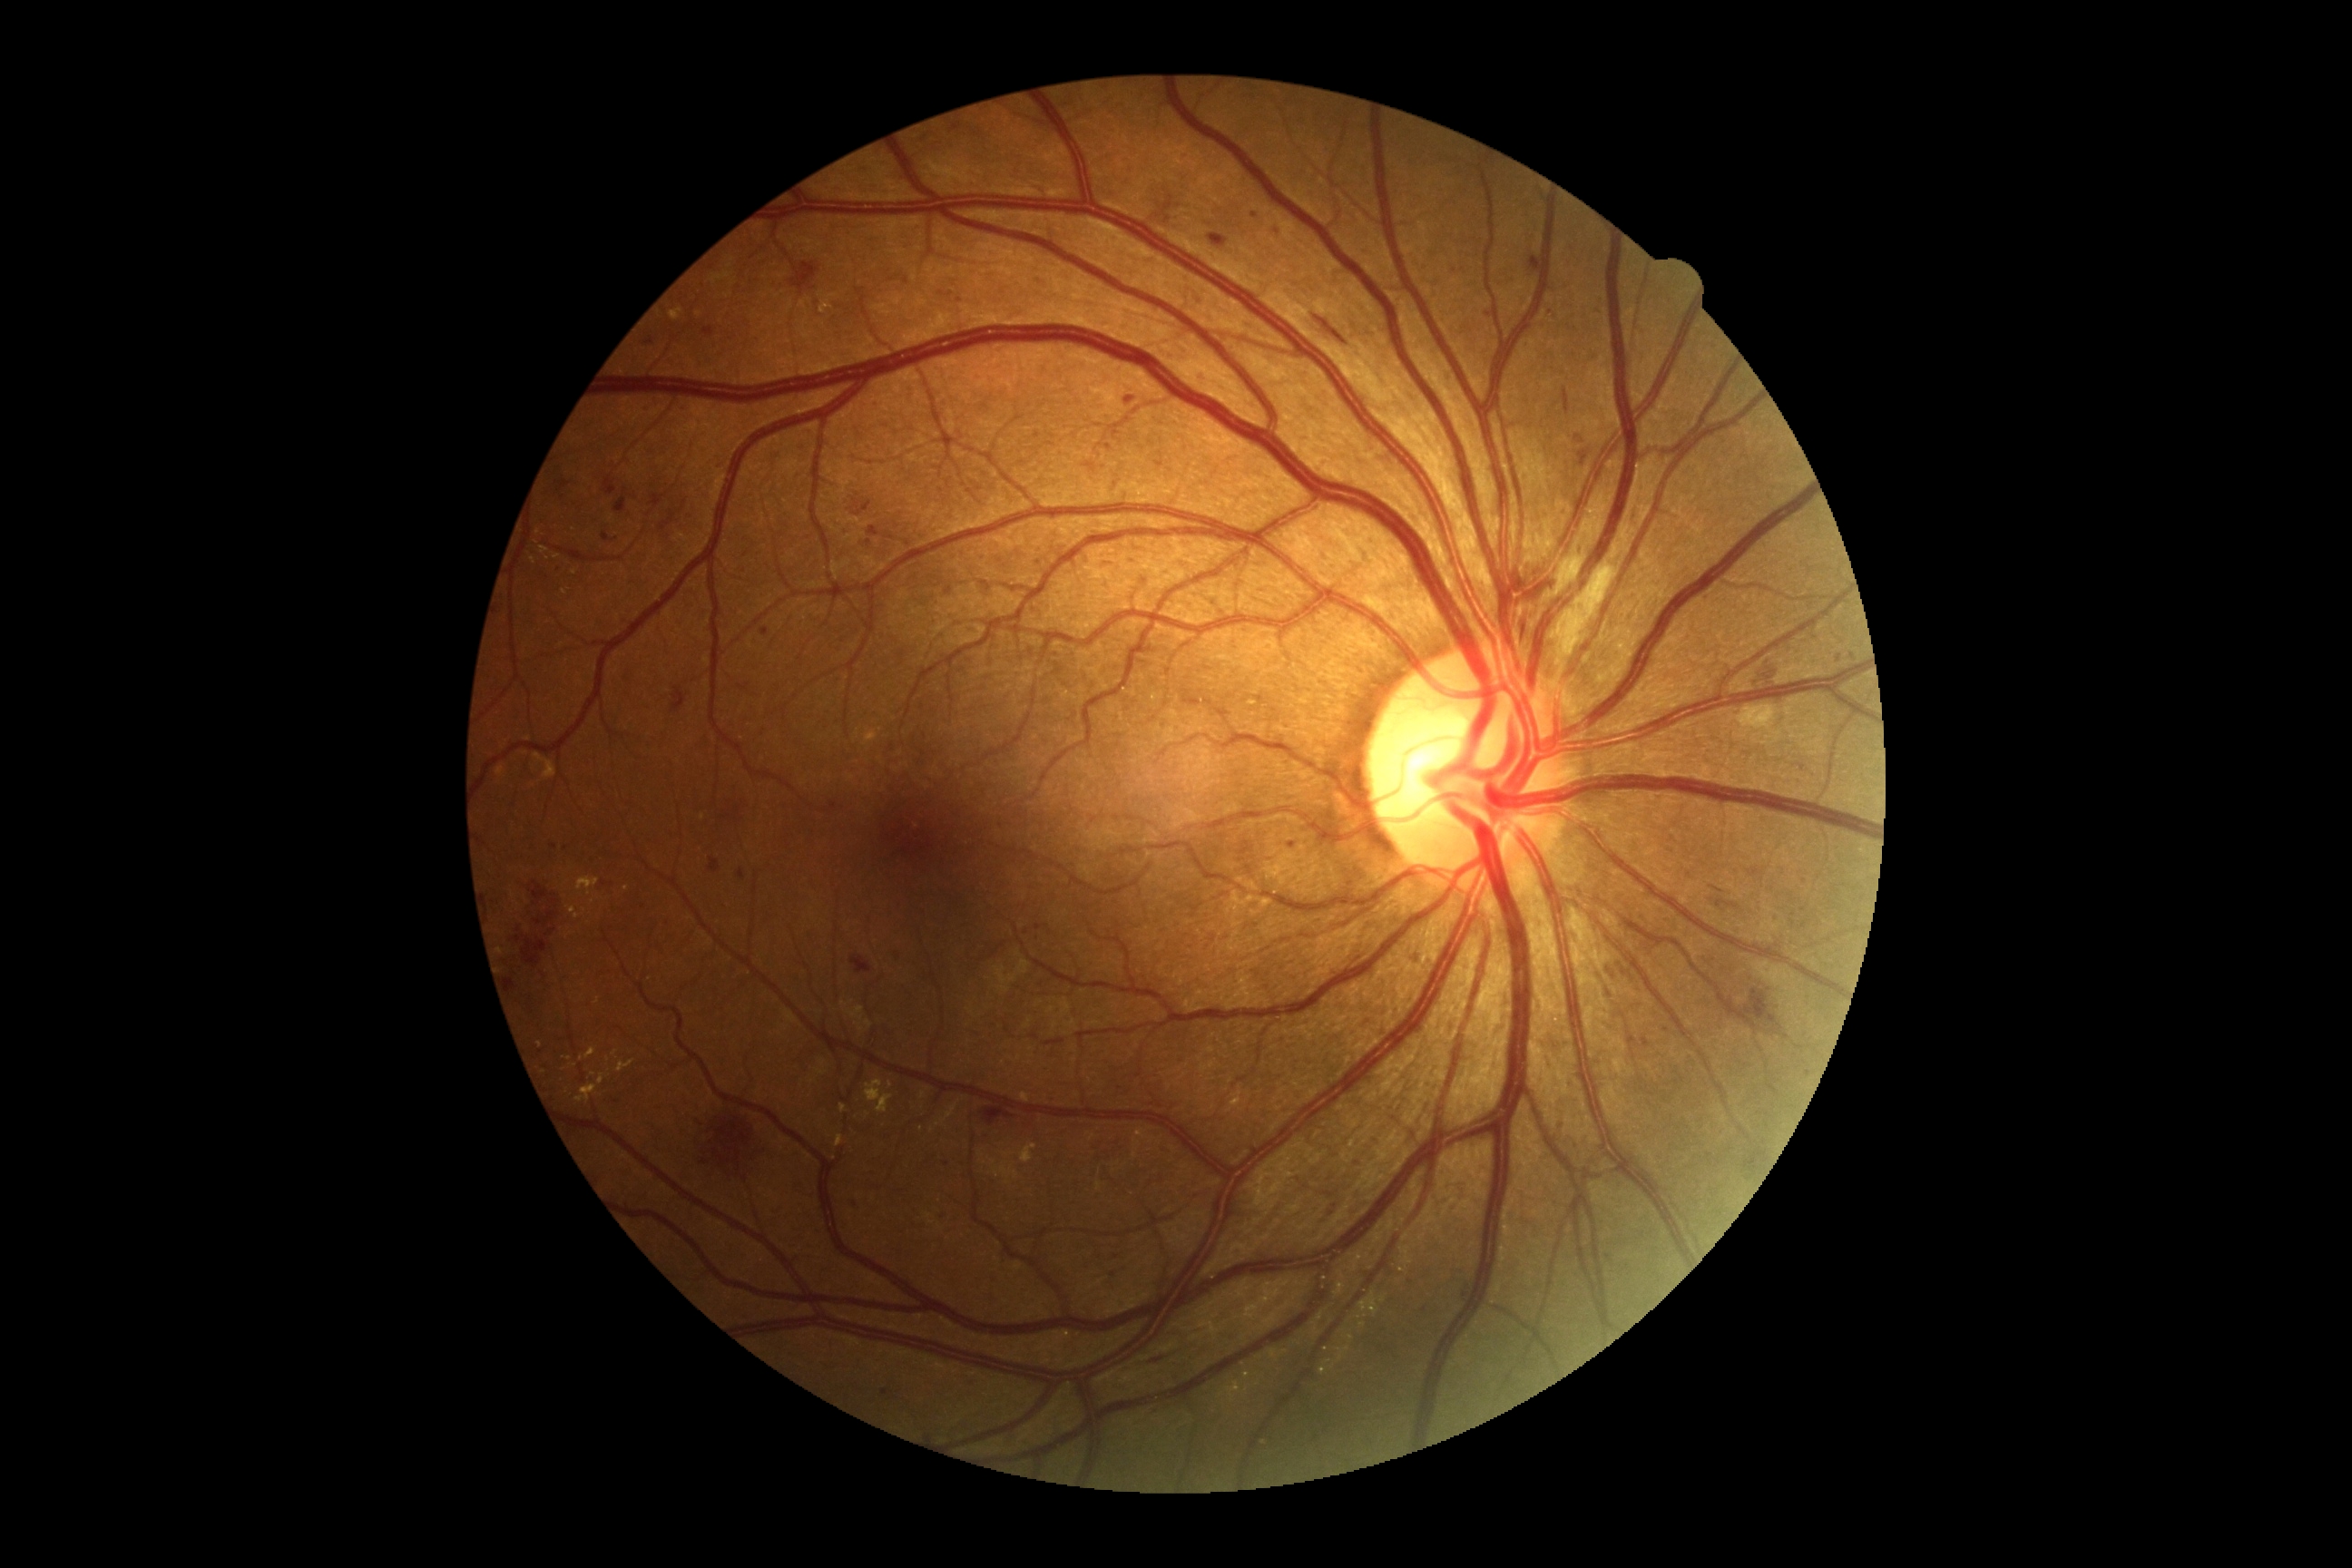 DR severity: severe non-proliferative diabetic retinopathy (grade 3).